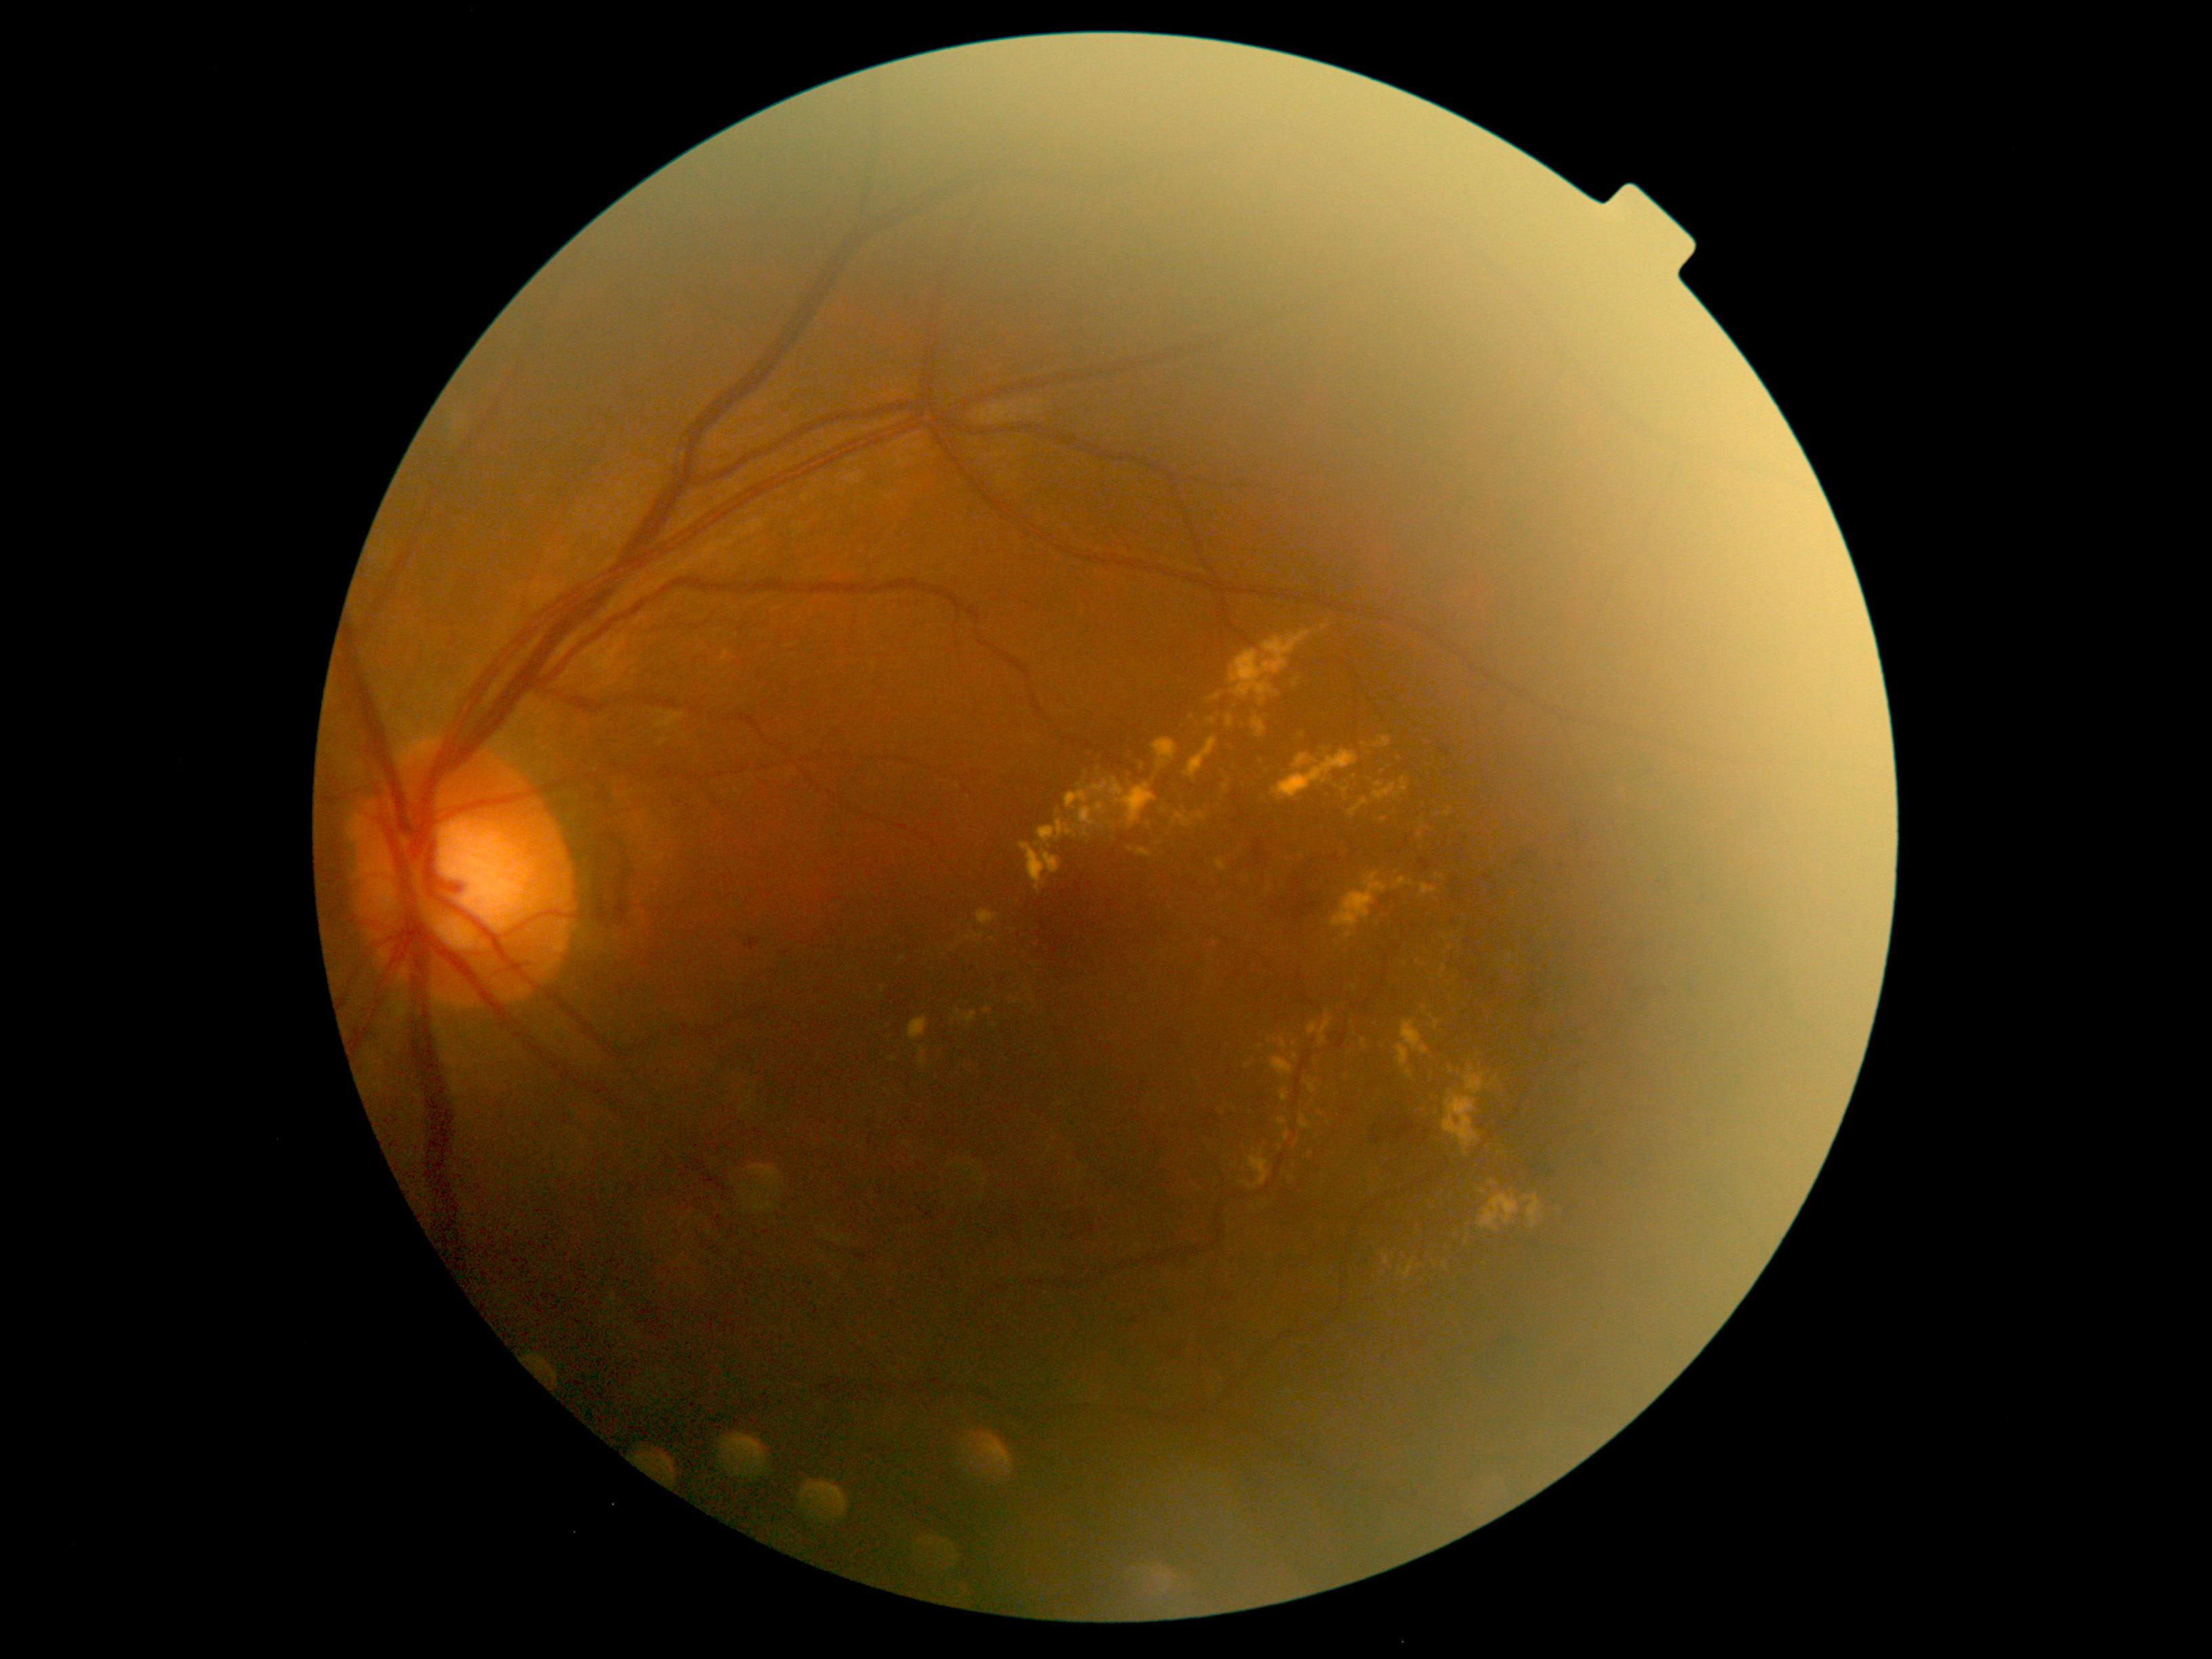 Diabetic retinopathy (DR) is grade 2.